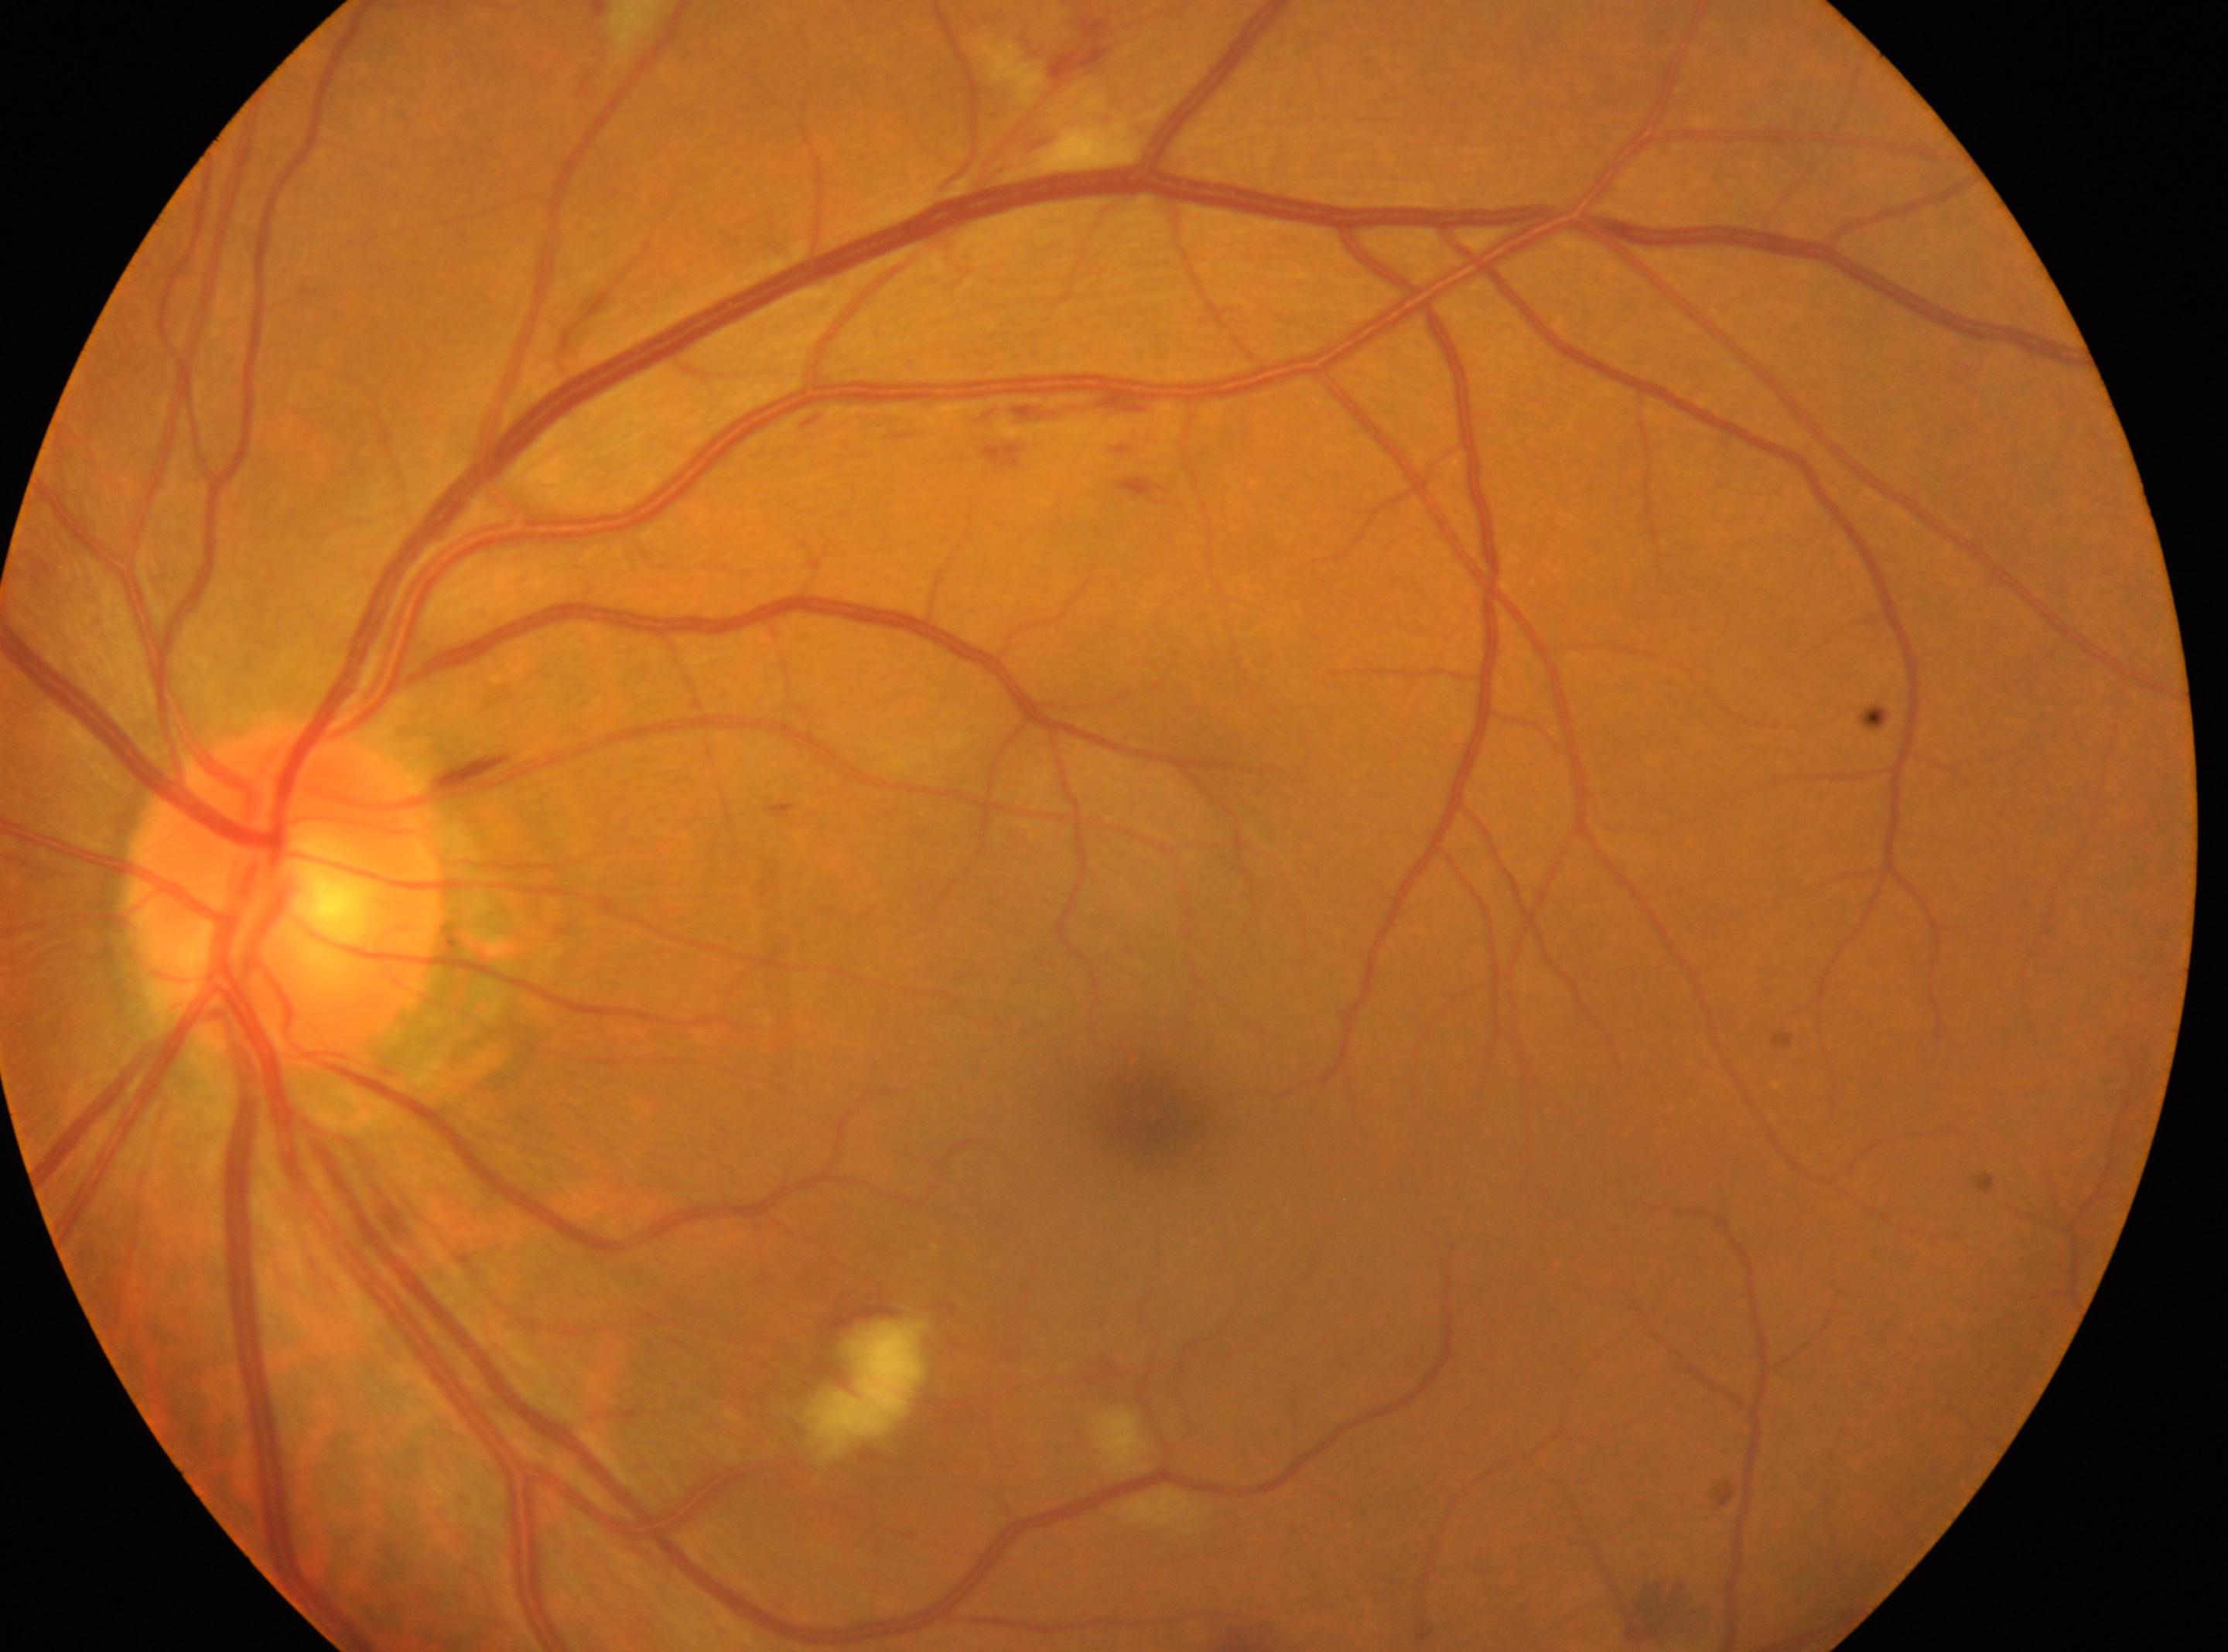 {"dr_grade": "2 (moderate NPDR)", "eye": "OS", "optic_disc": "282, 894", "fovea": "1160, 1121"}